Fundus photo — 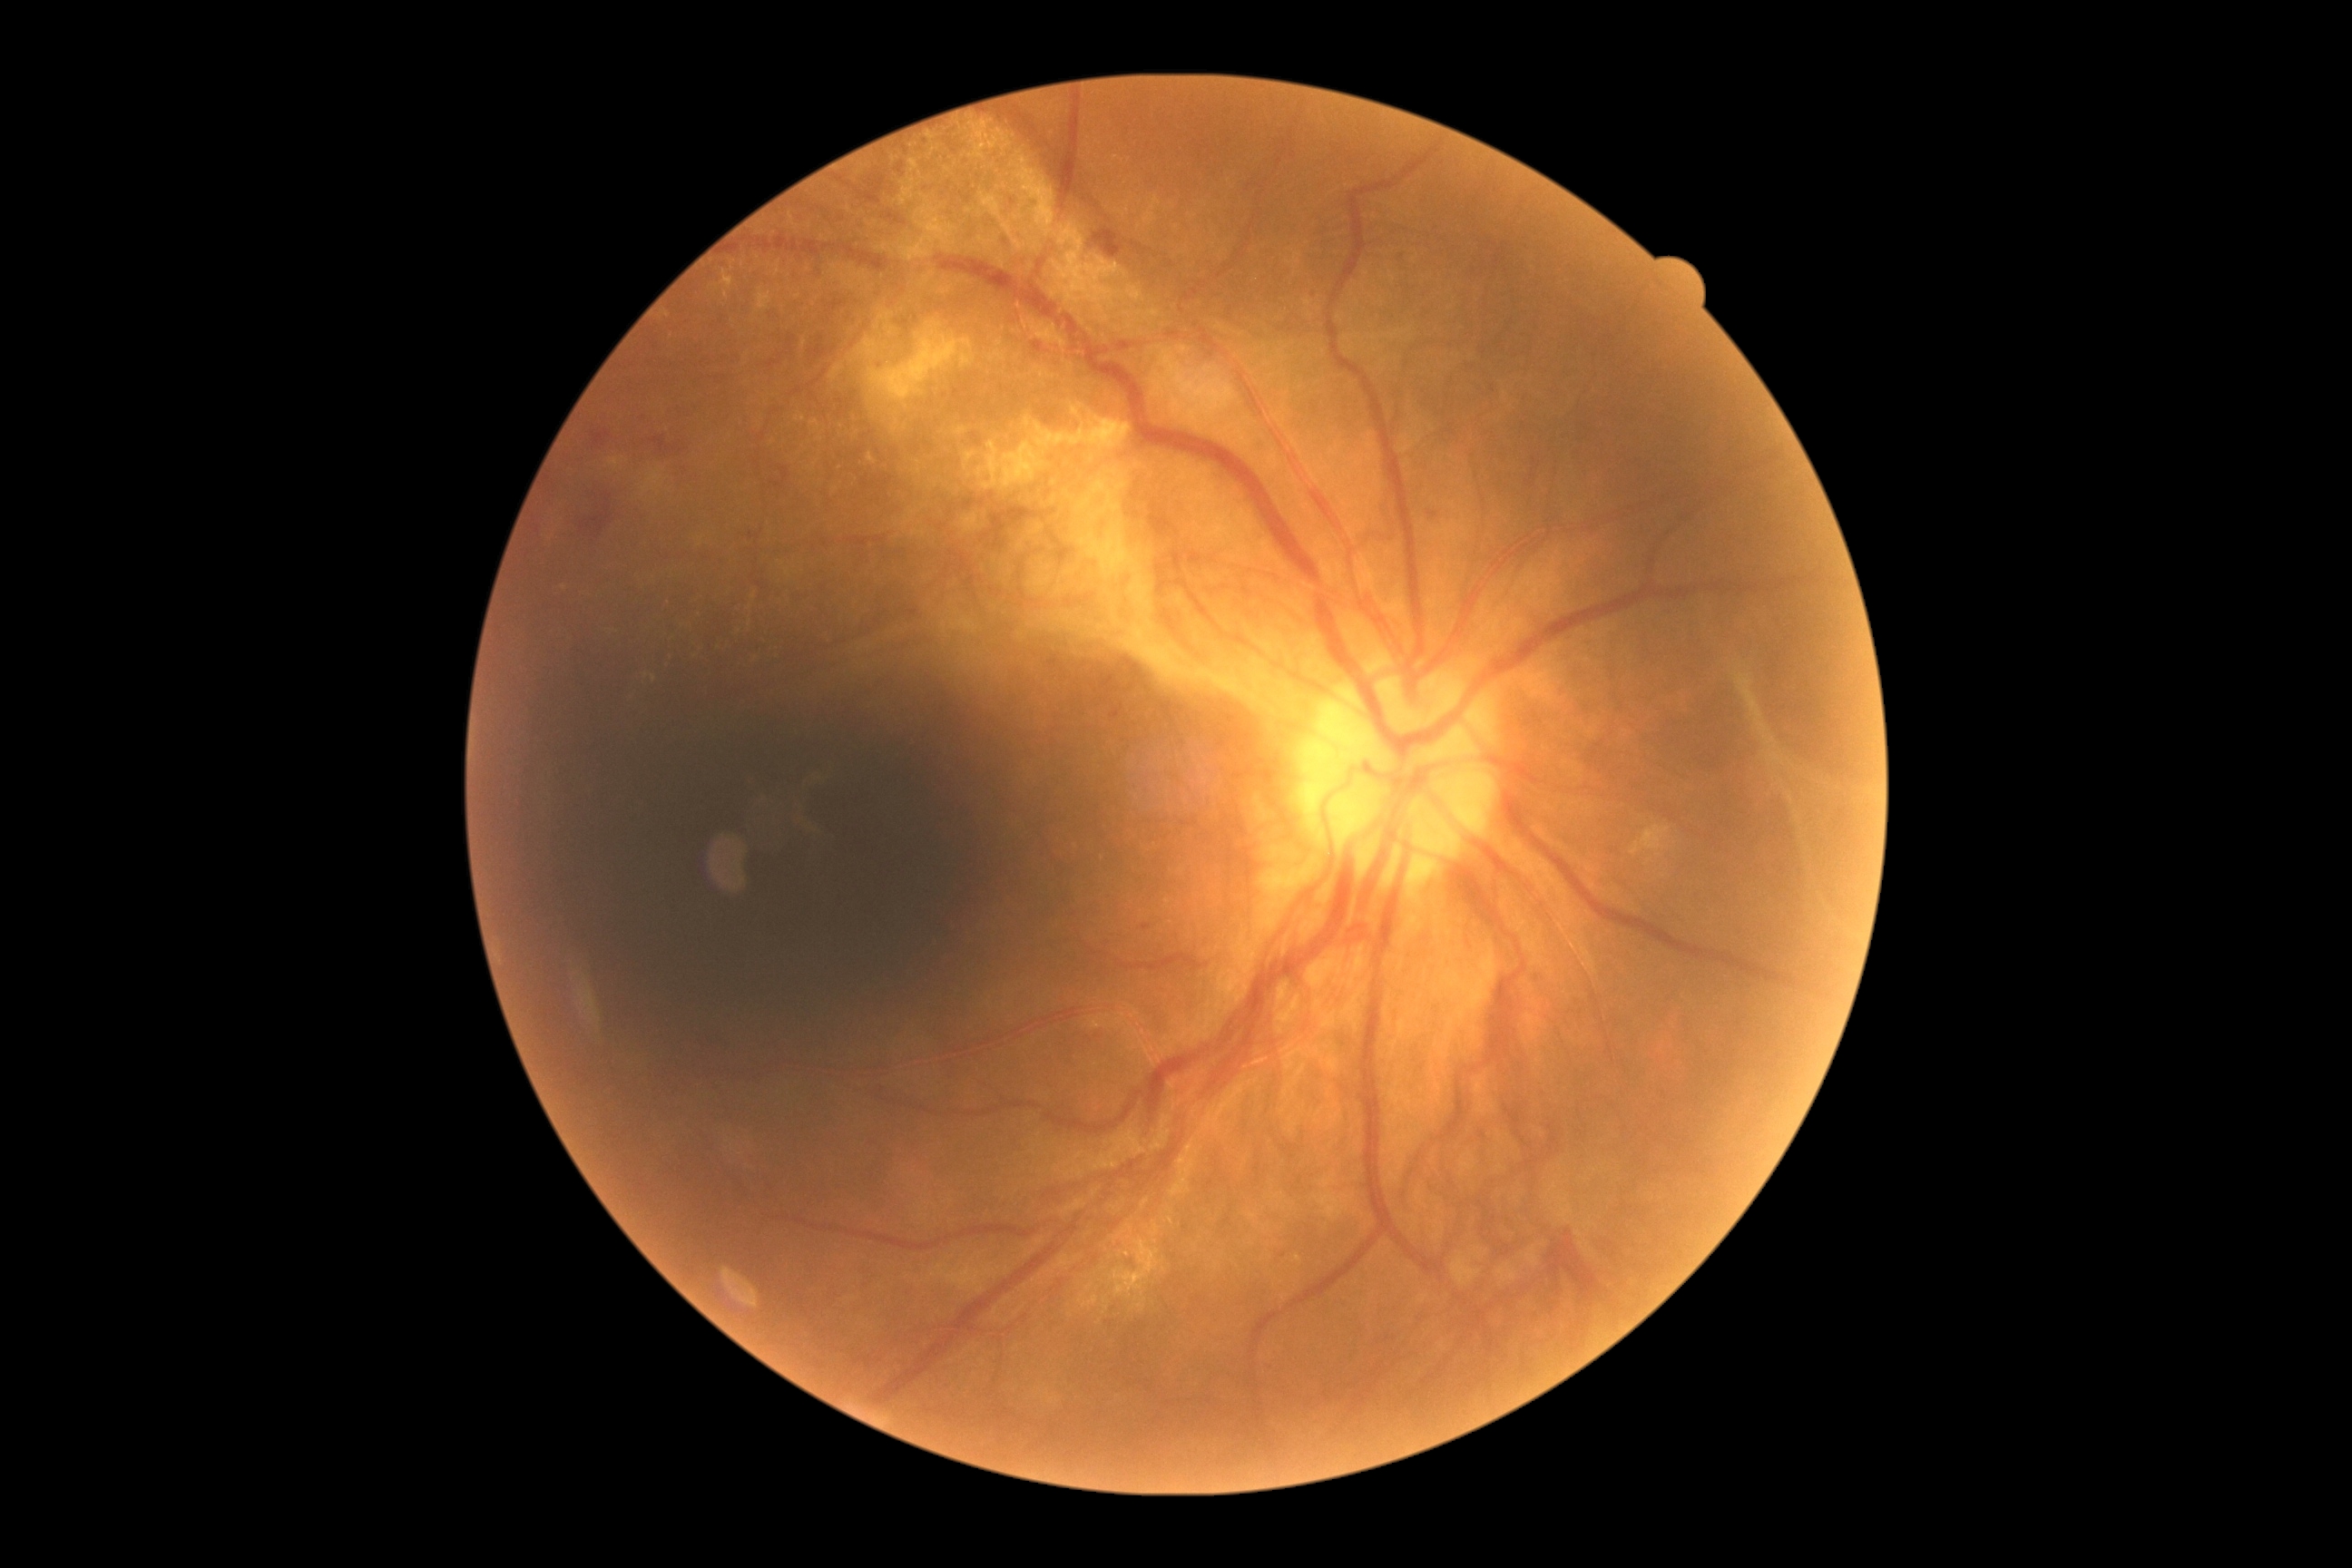

DR class=proliferative diabetic retinopathy; DR=grade 4 (PDR).